45° FOV.
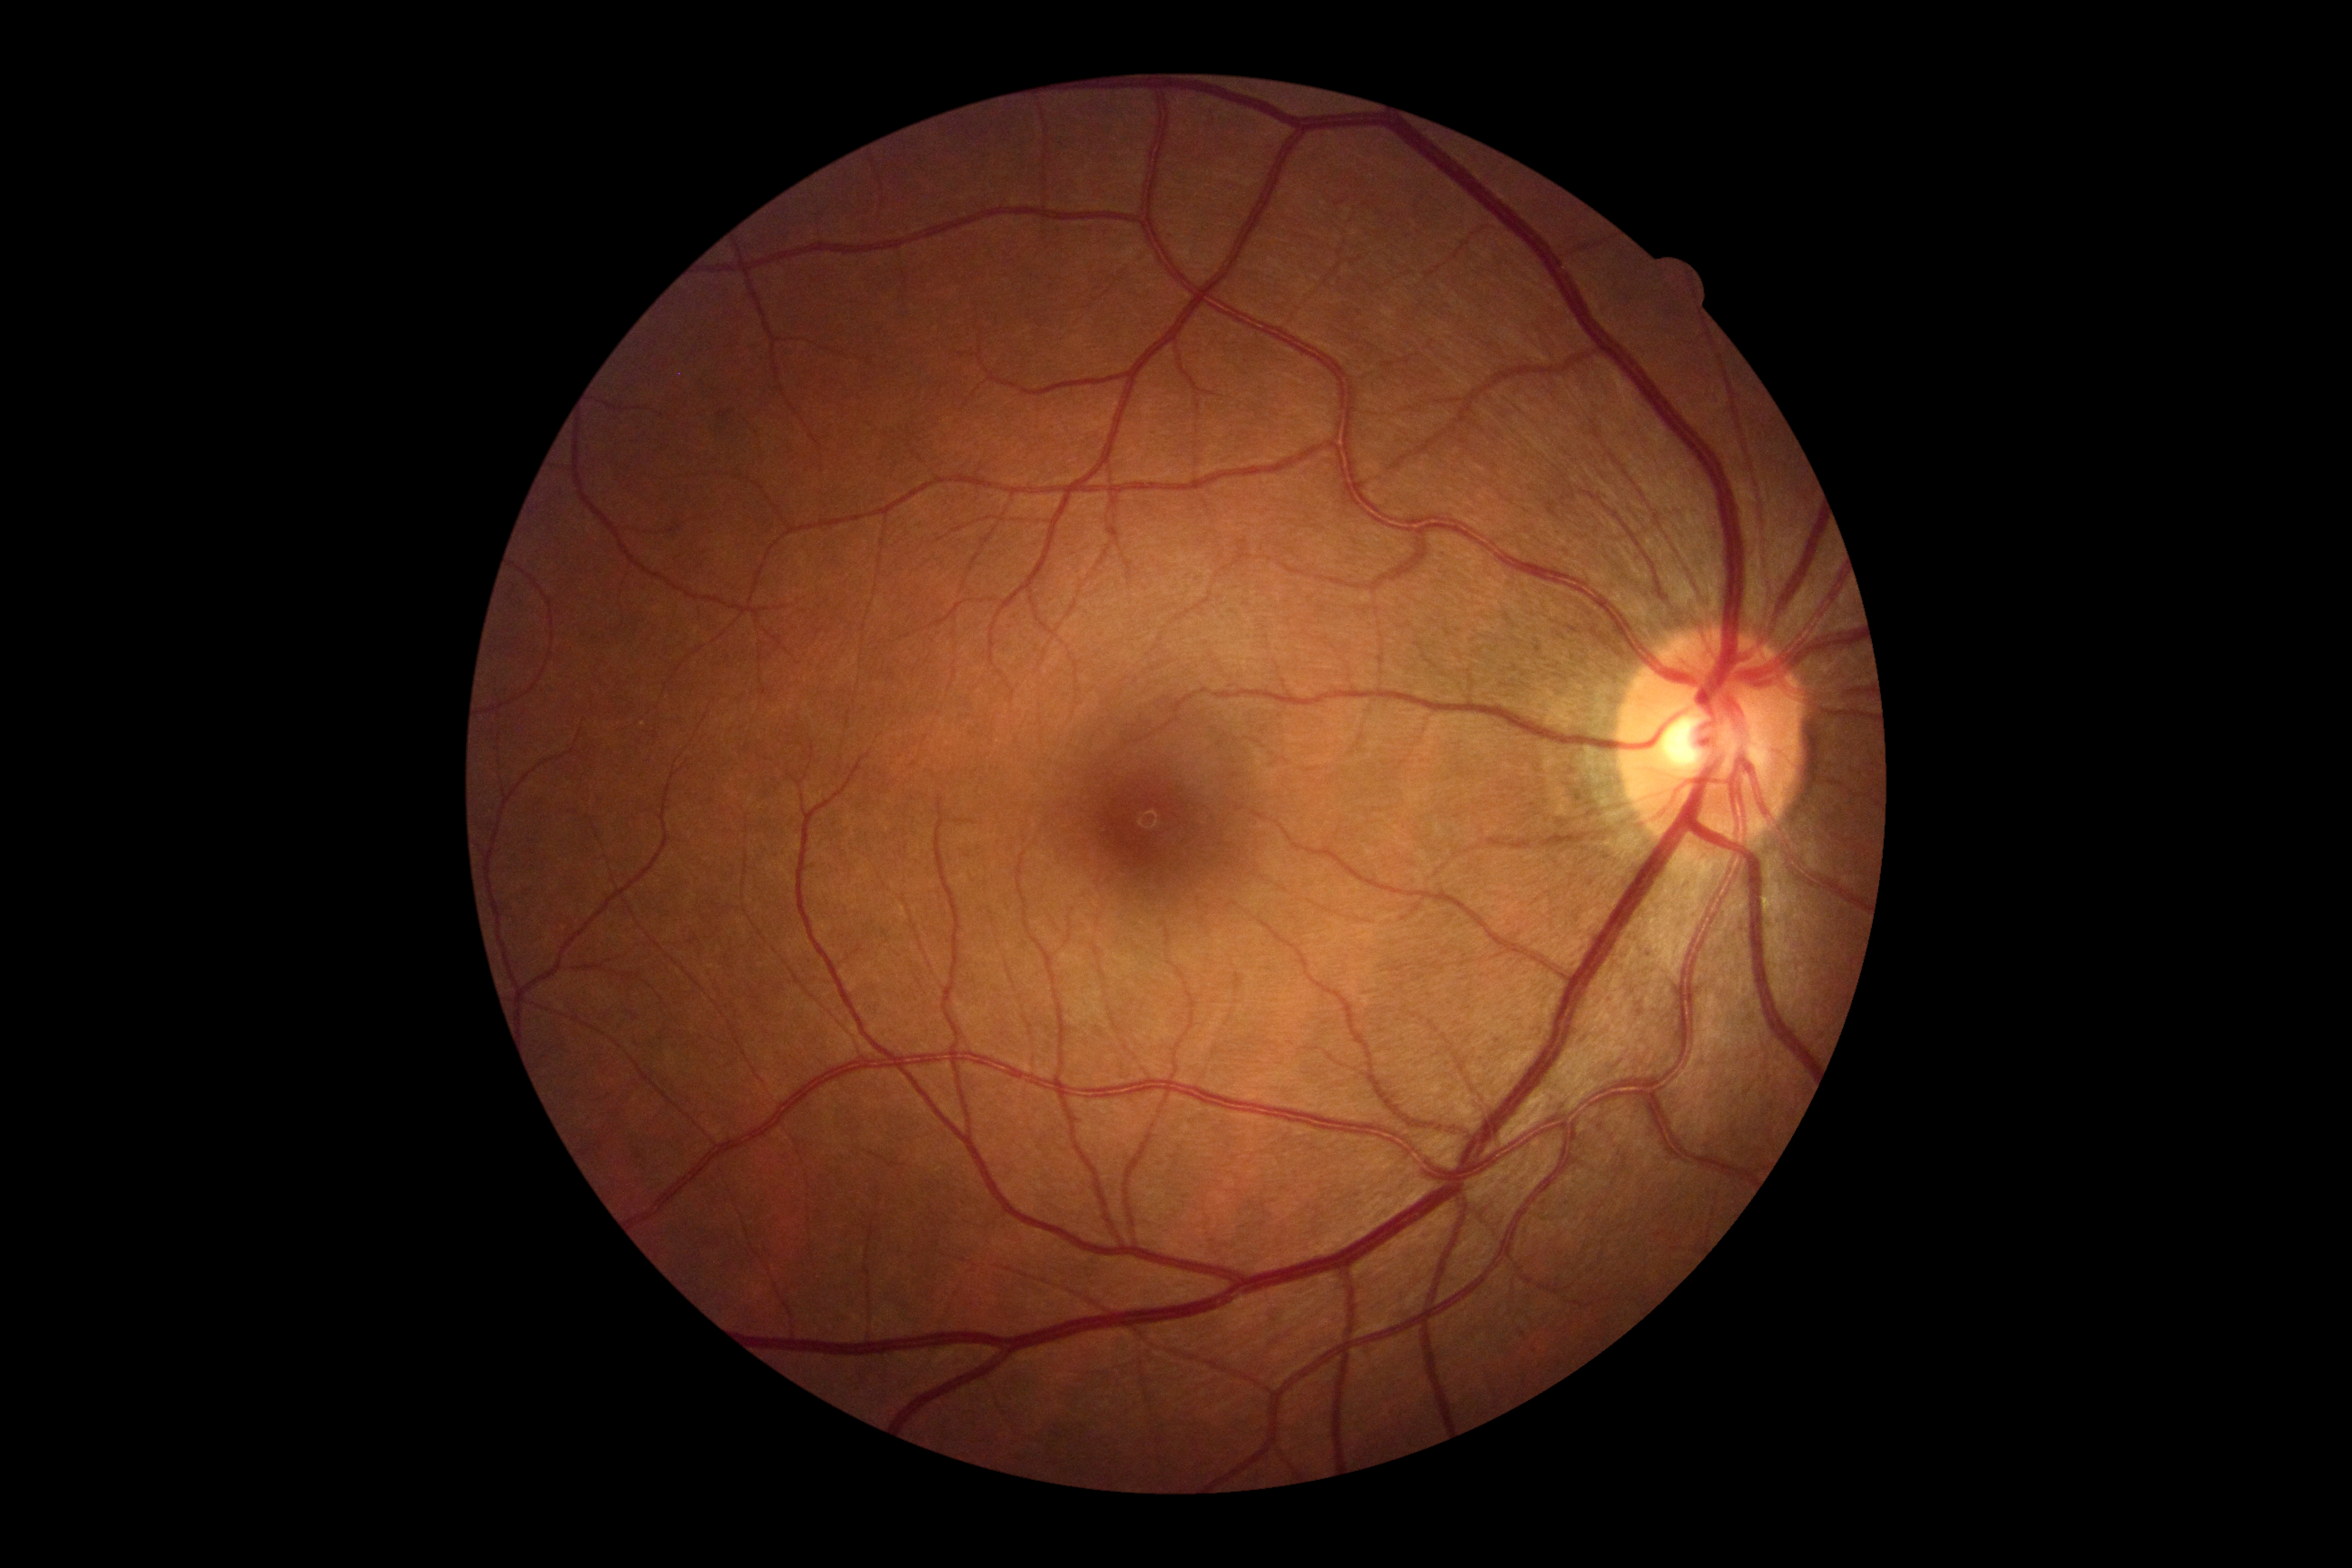
DR stage is no apparent retinopathy (grade 0).